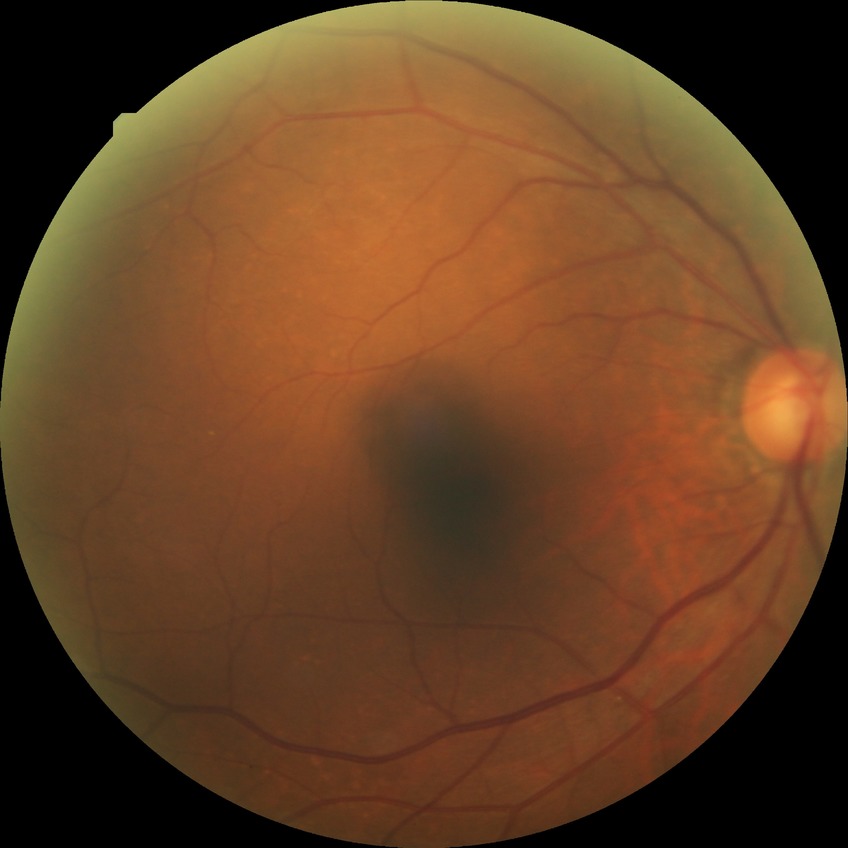

Diabetic retinopathy (DR) is NDR (no diabetic retinopathy).